Nonmydriatic fundus photograph · 45° FOV · modified Davis classification: 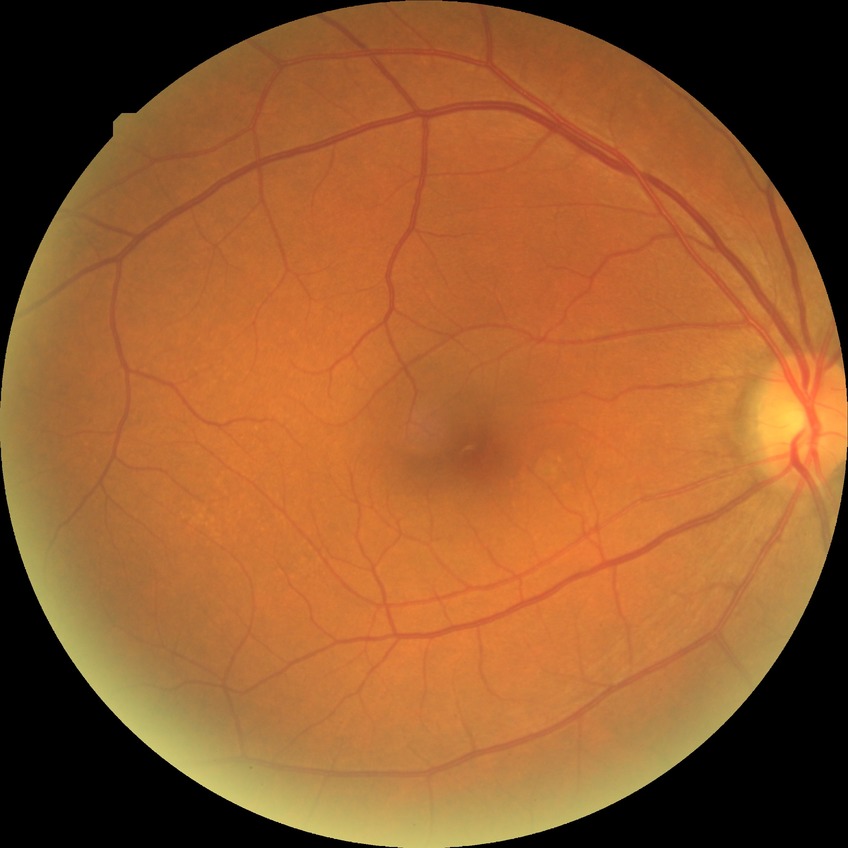

DR severity: NDR. No DR findings.